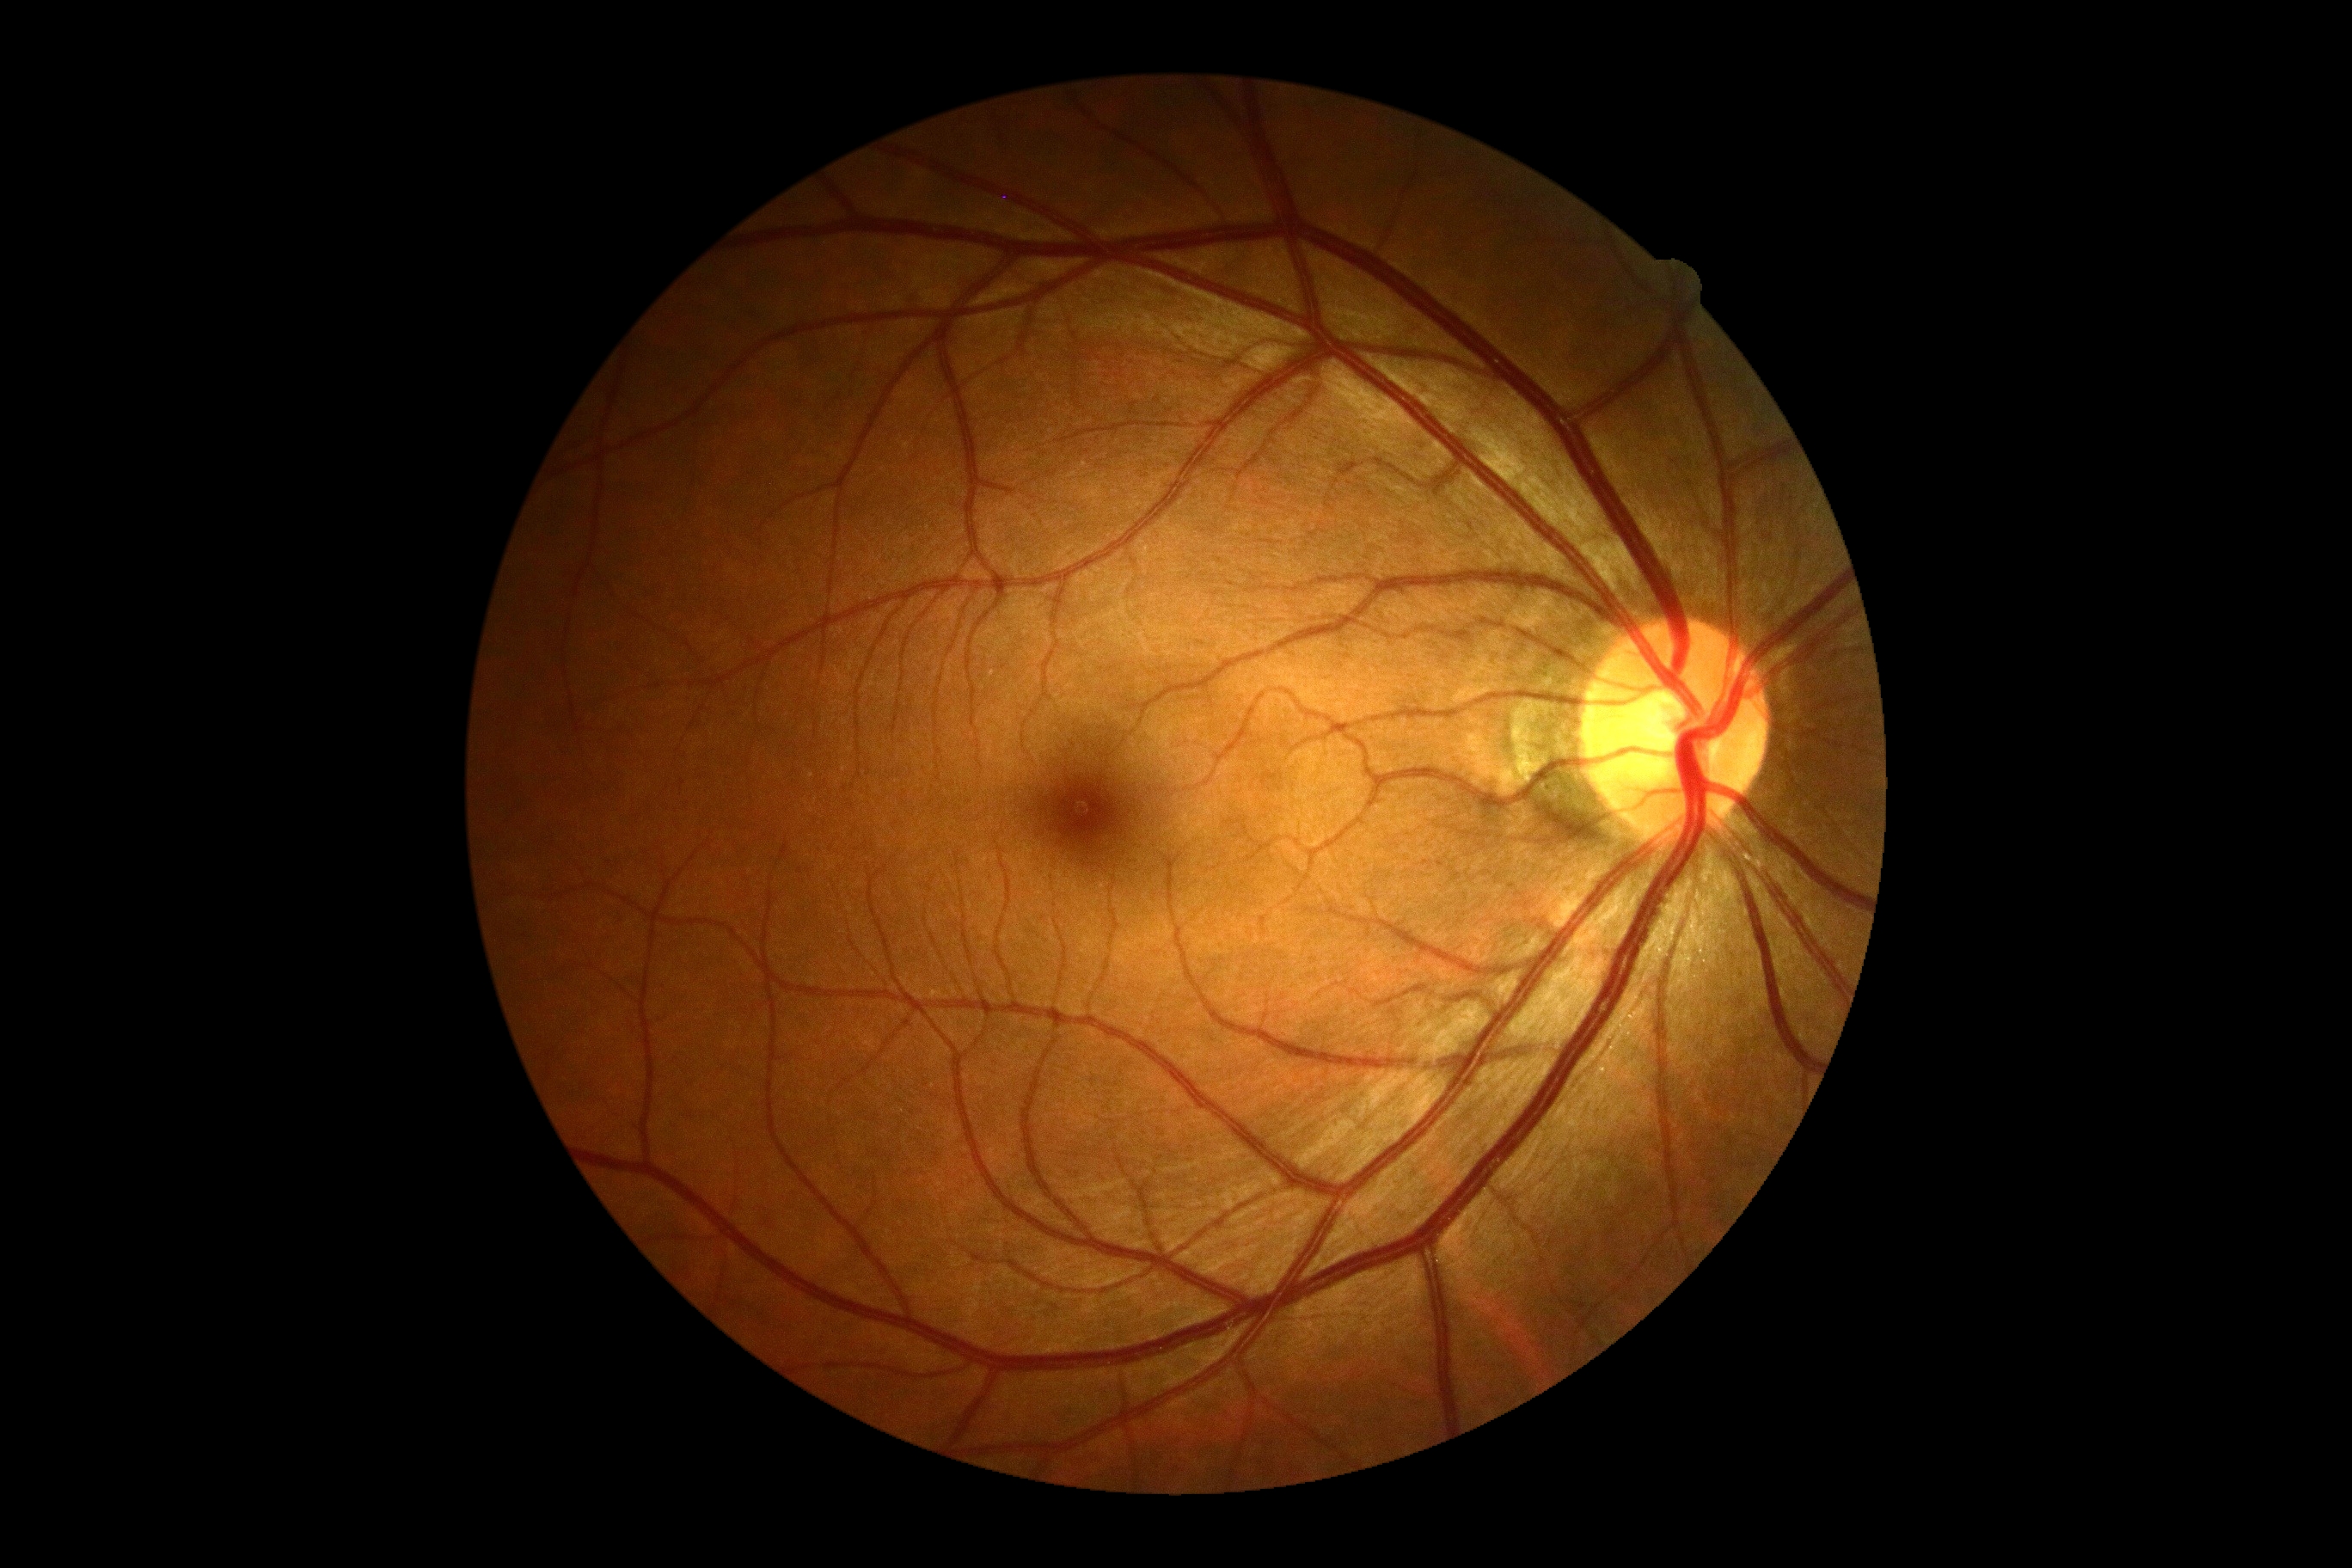 DR grade: 0 (no apparent retinopathy)